DR severity per modified Davis staging.
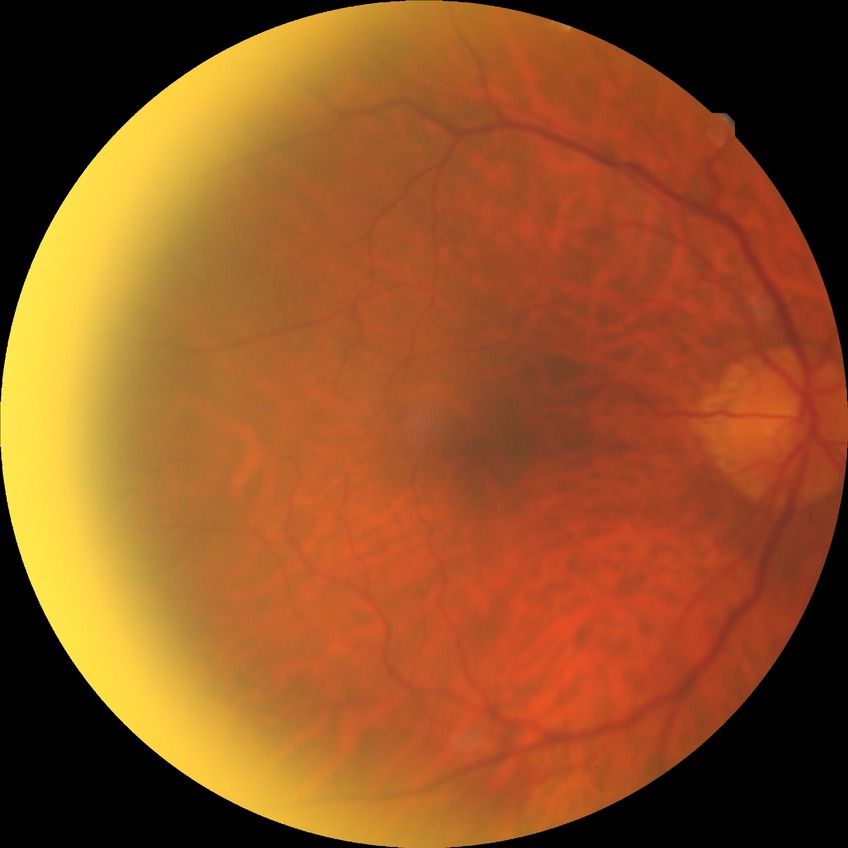
Diabetic retinopathy (DR): no diabetic retinopathy (NDR).